2352x1568px, 45° FOV: 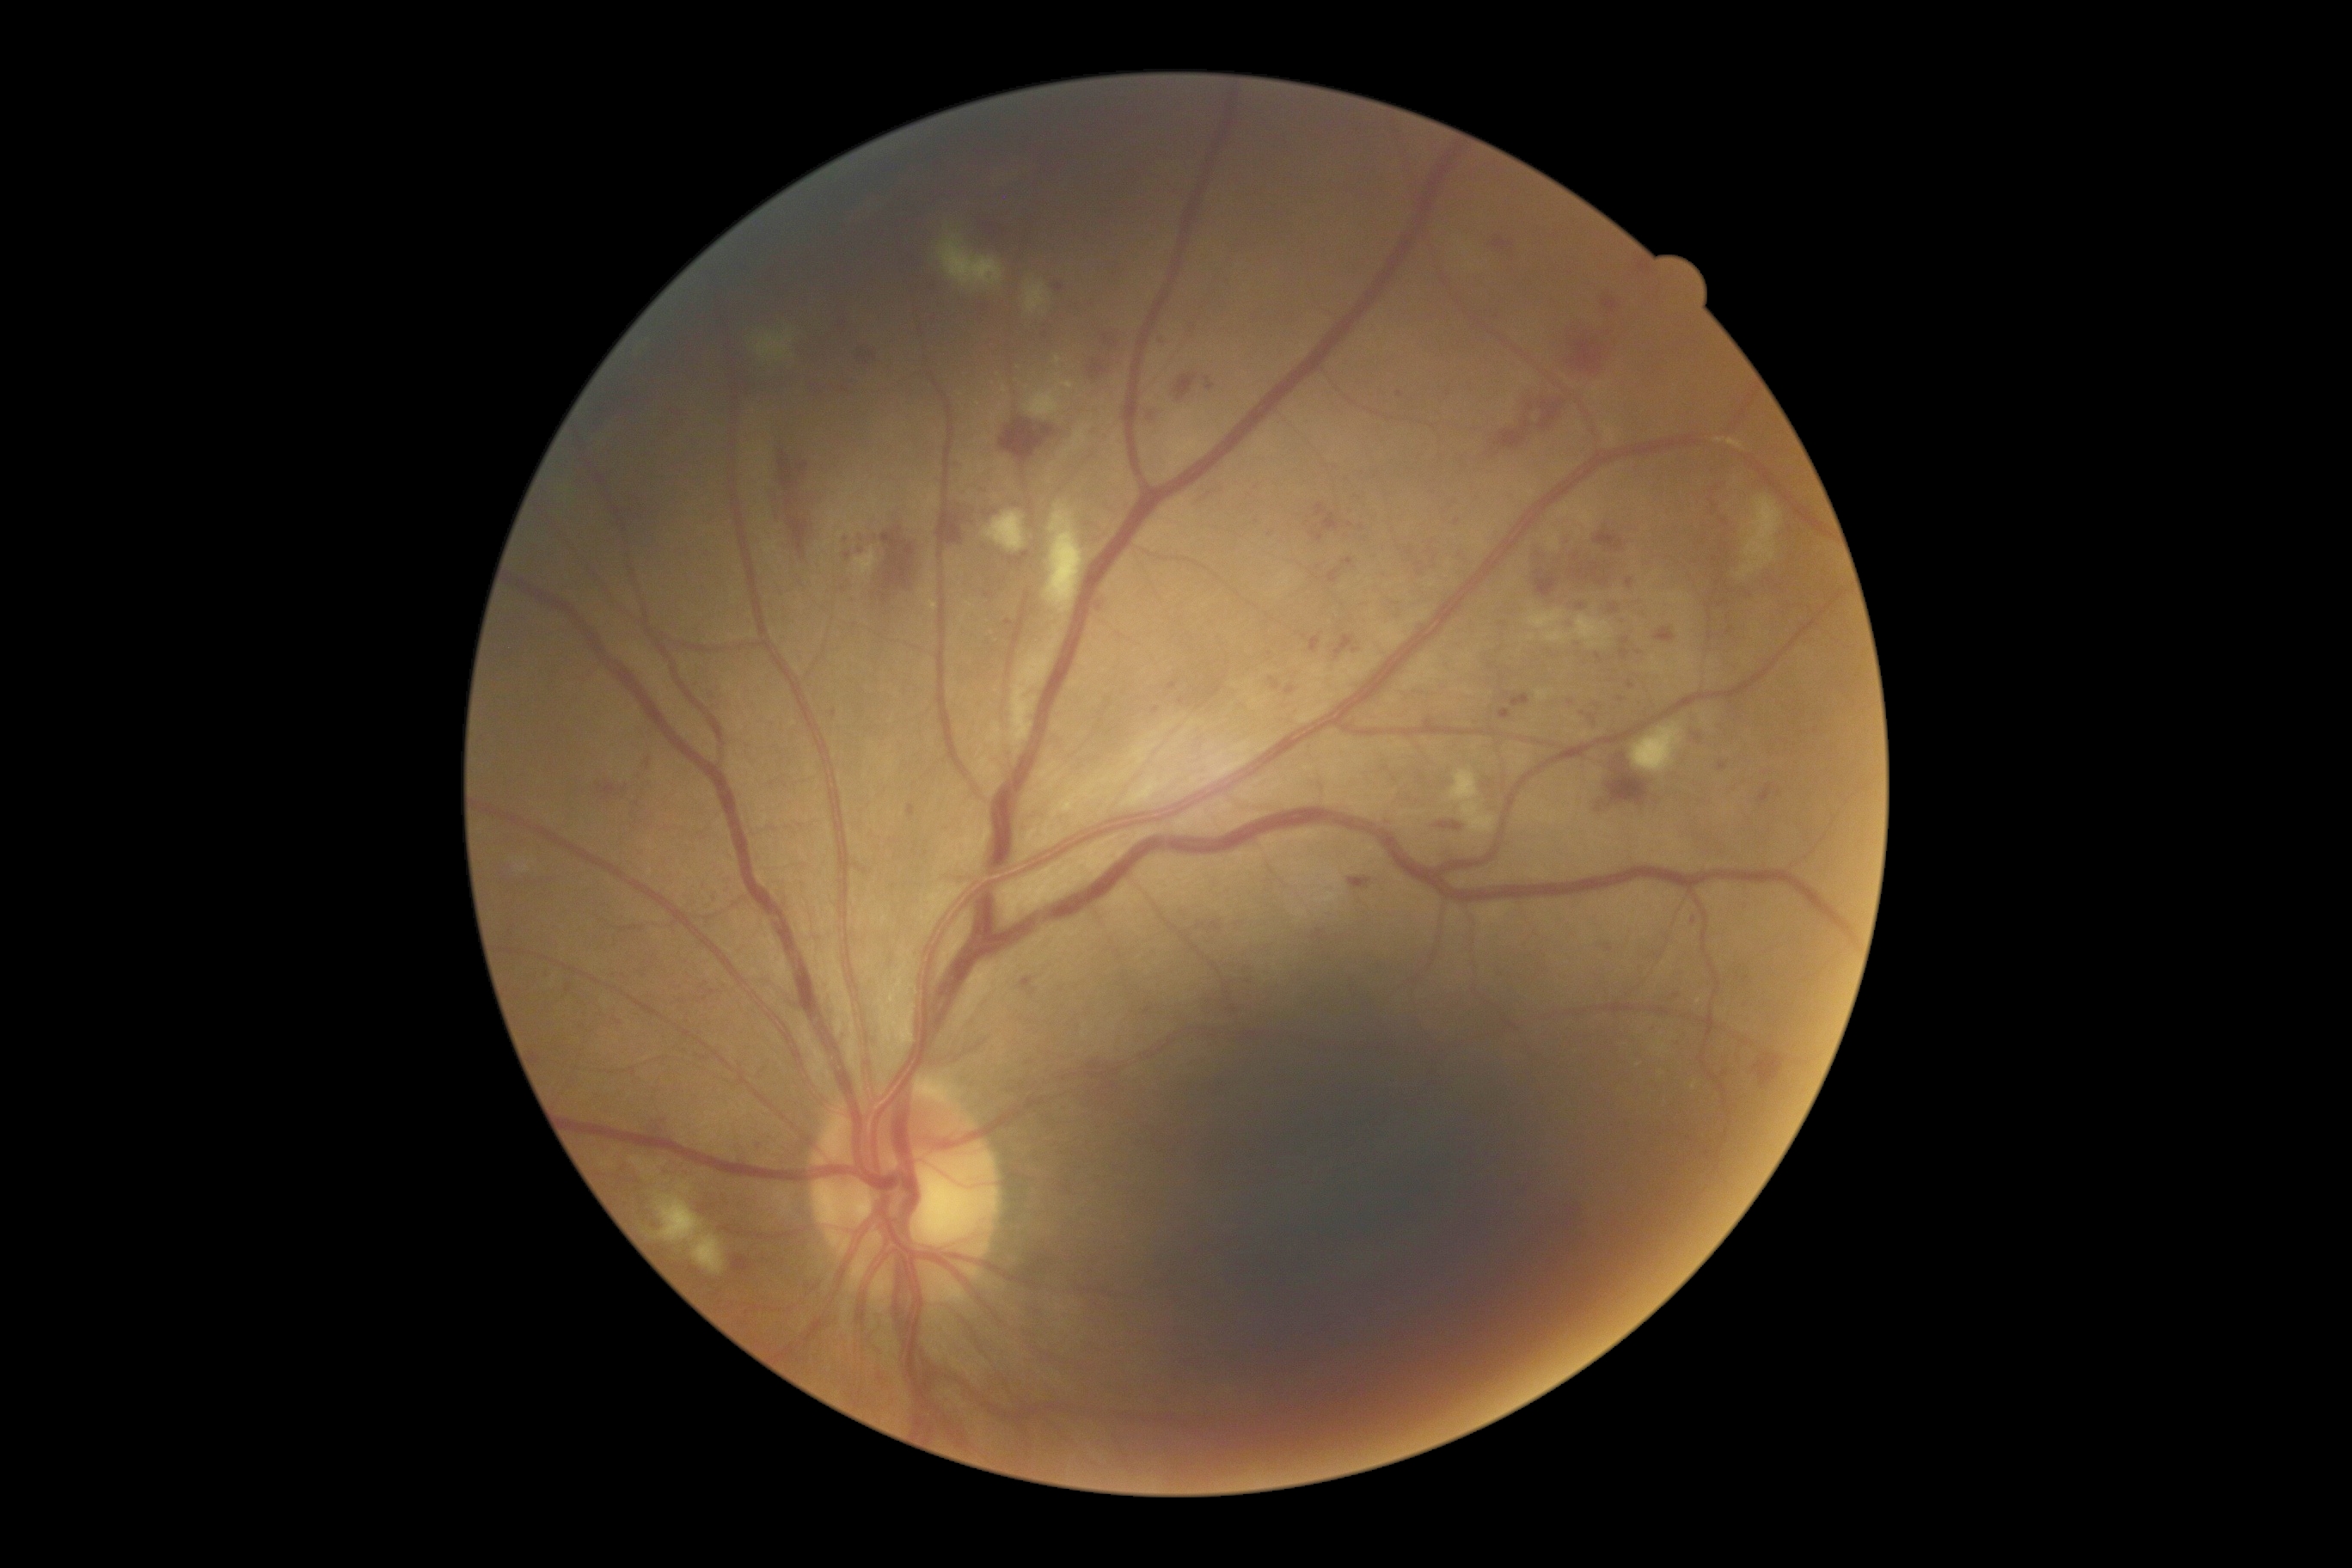 Retinopathy grade: 2 (moderate NPDR).